Macula-centered field; captured after pupil dilation; CFP — 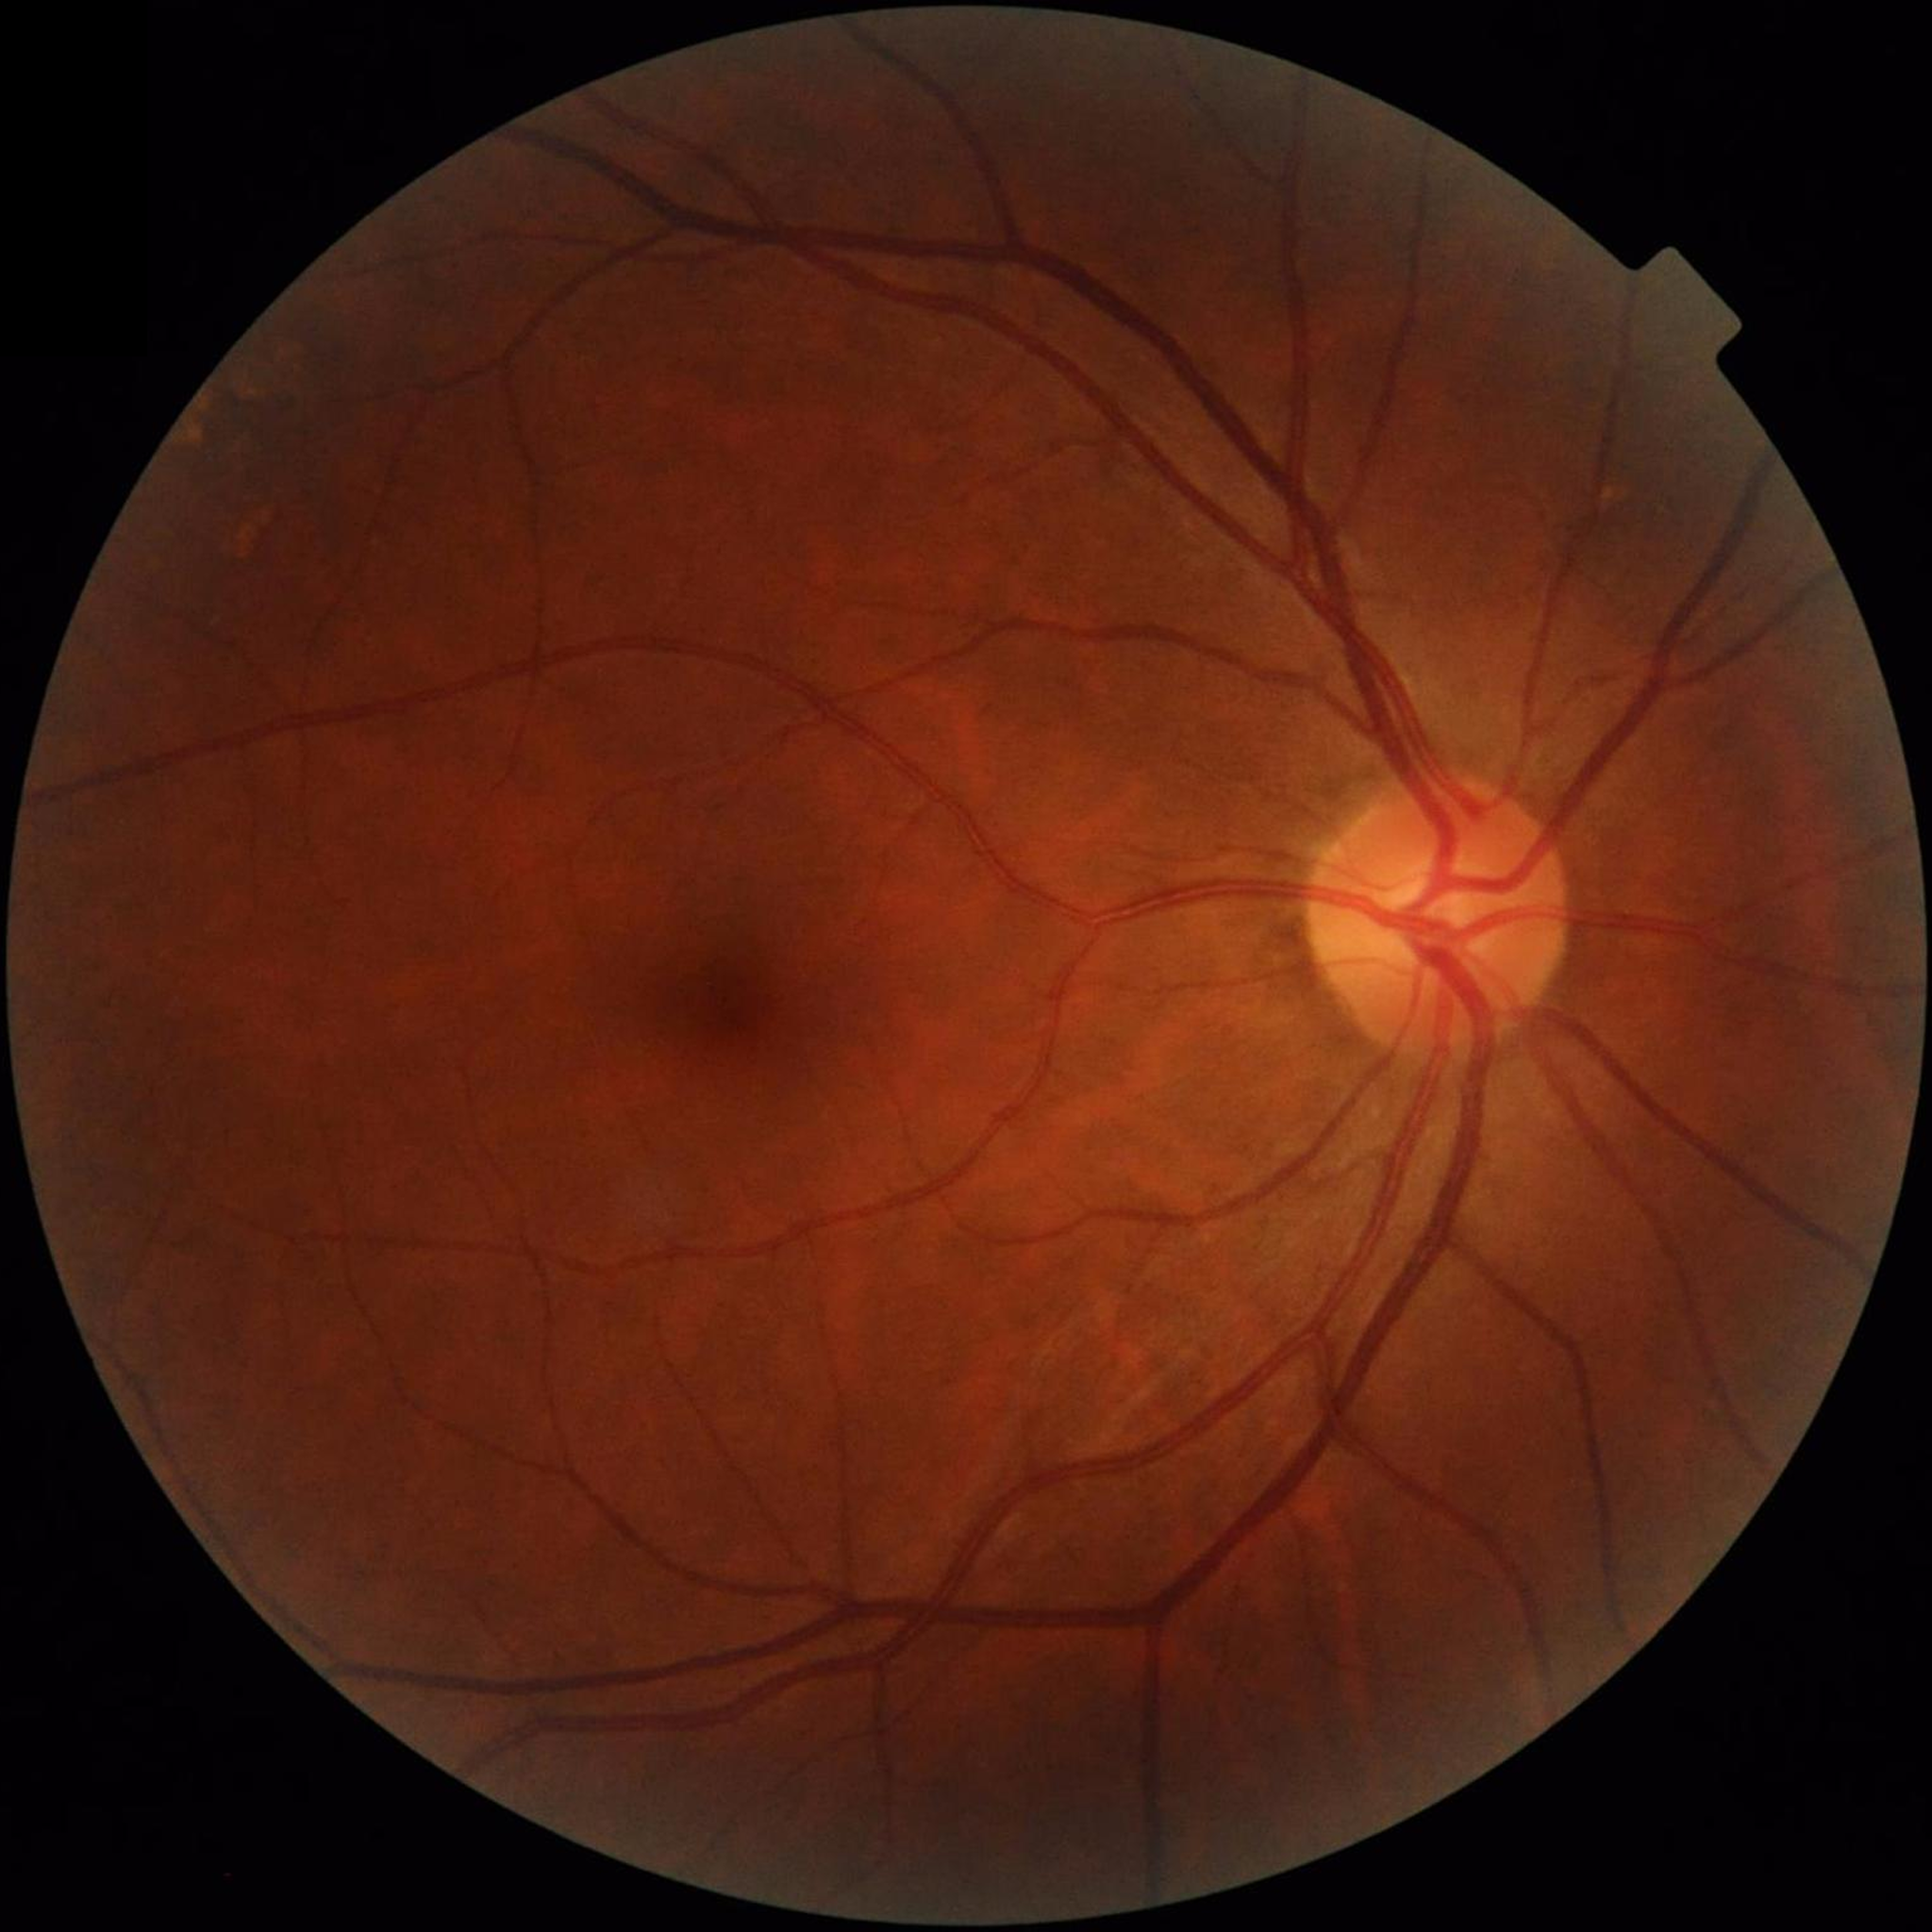
No findings of AMD, diabetic retinopathy, or glaucoma. Photo quality: adequate.